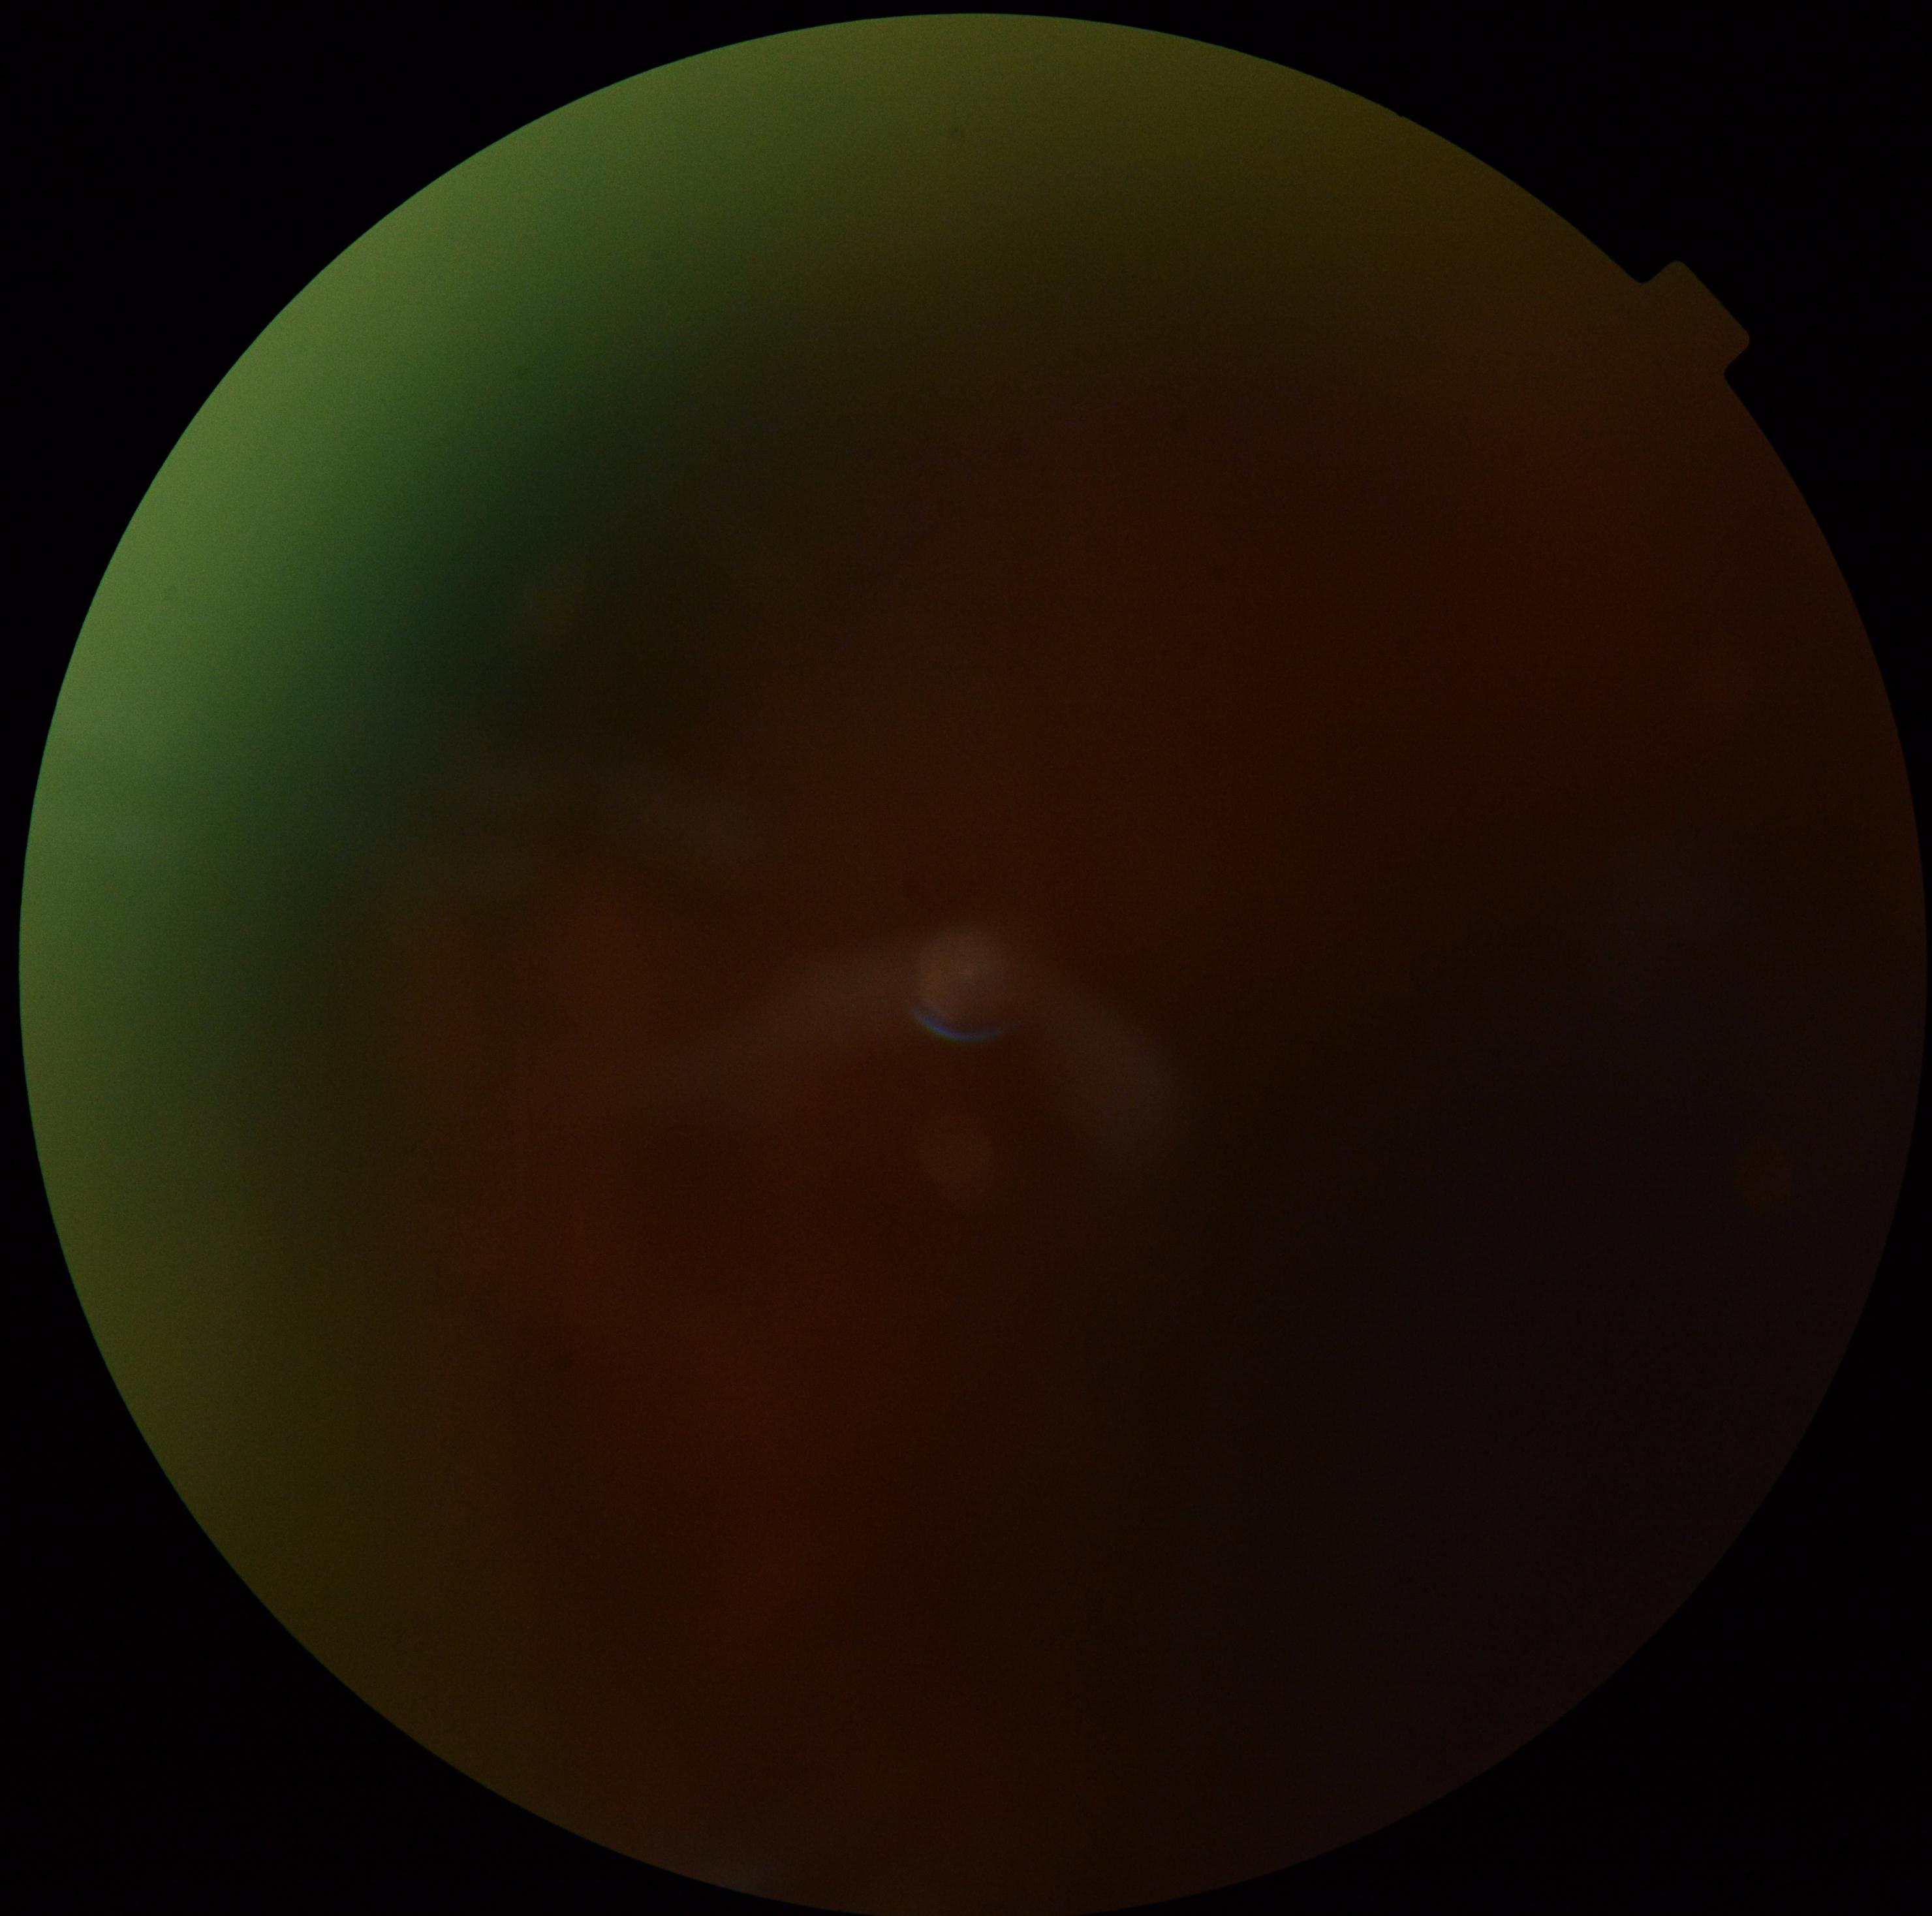

Image quality is insufficient for diabetic retinopathy assessment. DR severity is ungradable due to poor image quality.